Modified Davis grading
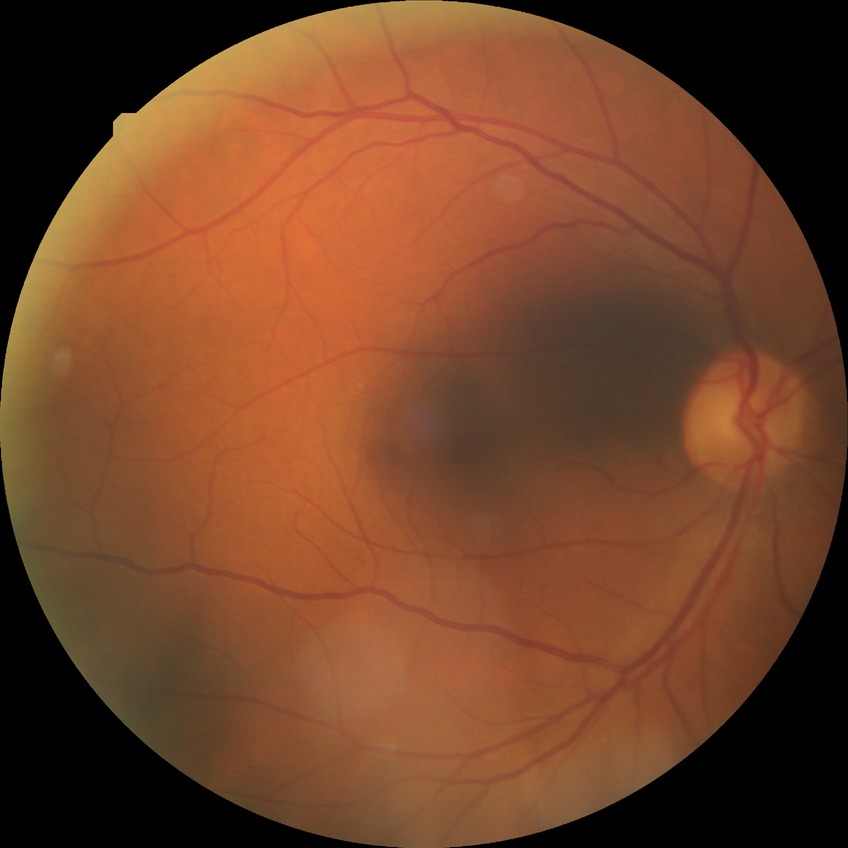 Davis grading = no diabetic retinopathy.